Davis DR grading, without pupil dilation, 45 degree fundus photograph: 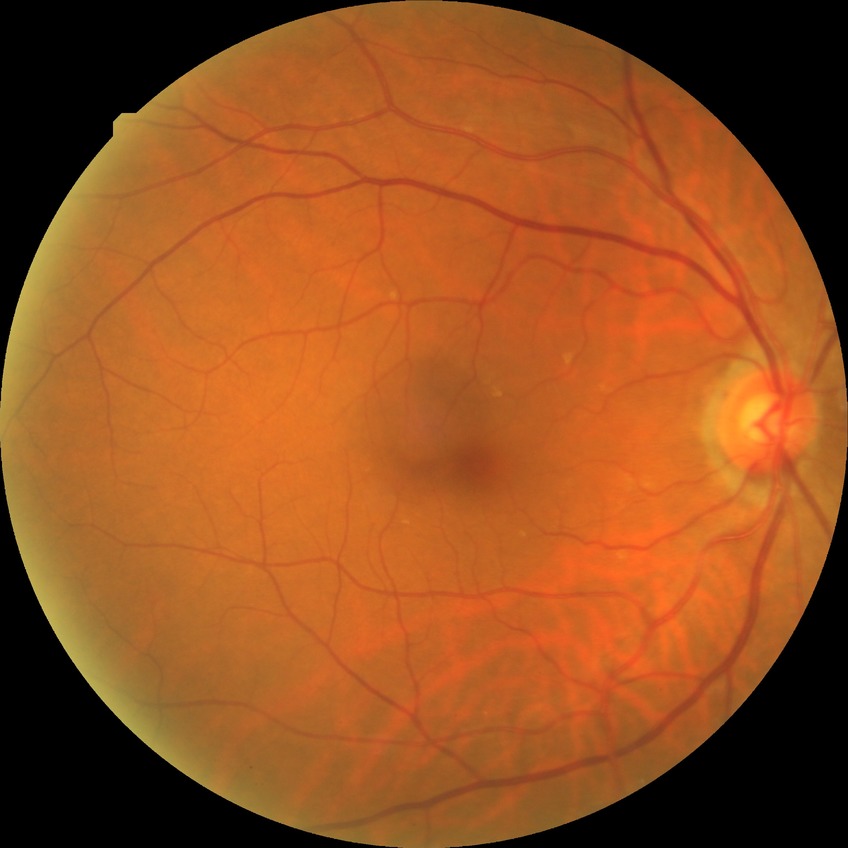 Modified Davis grade: NDR. No diabetic retinal disease findings.